45° FOV
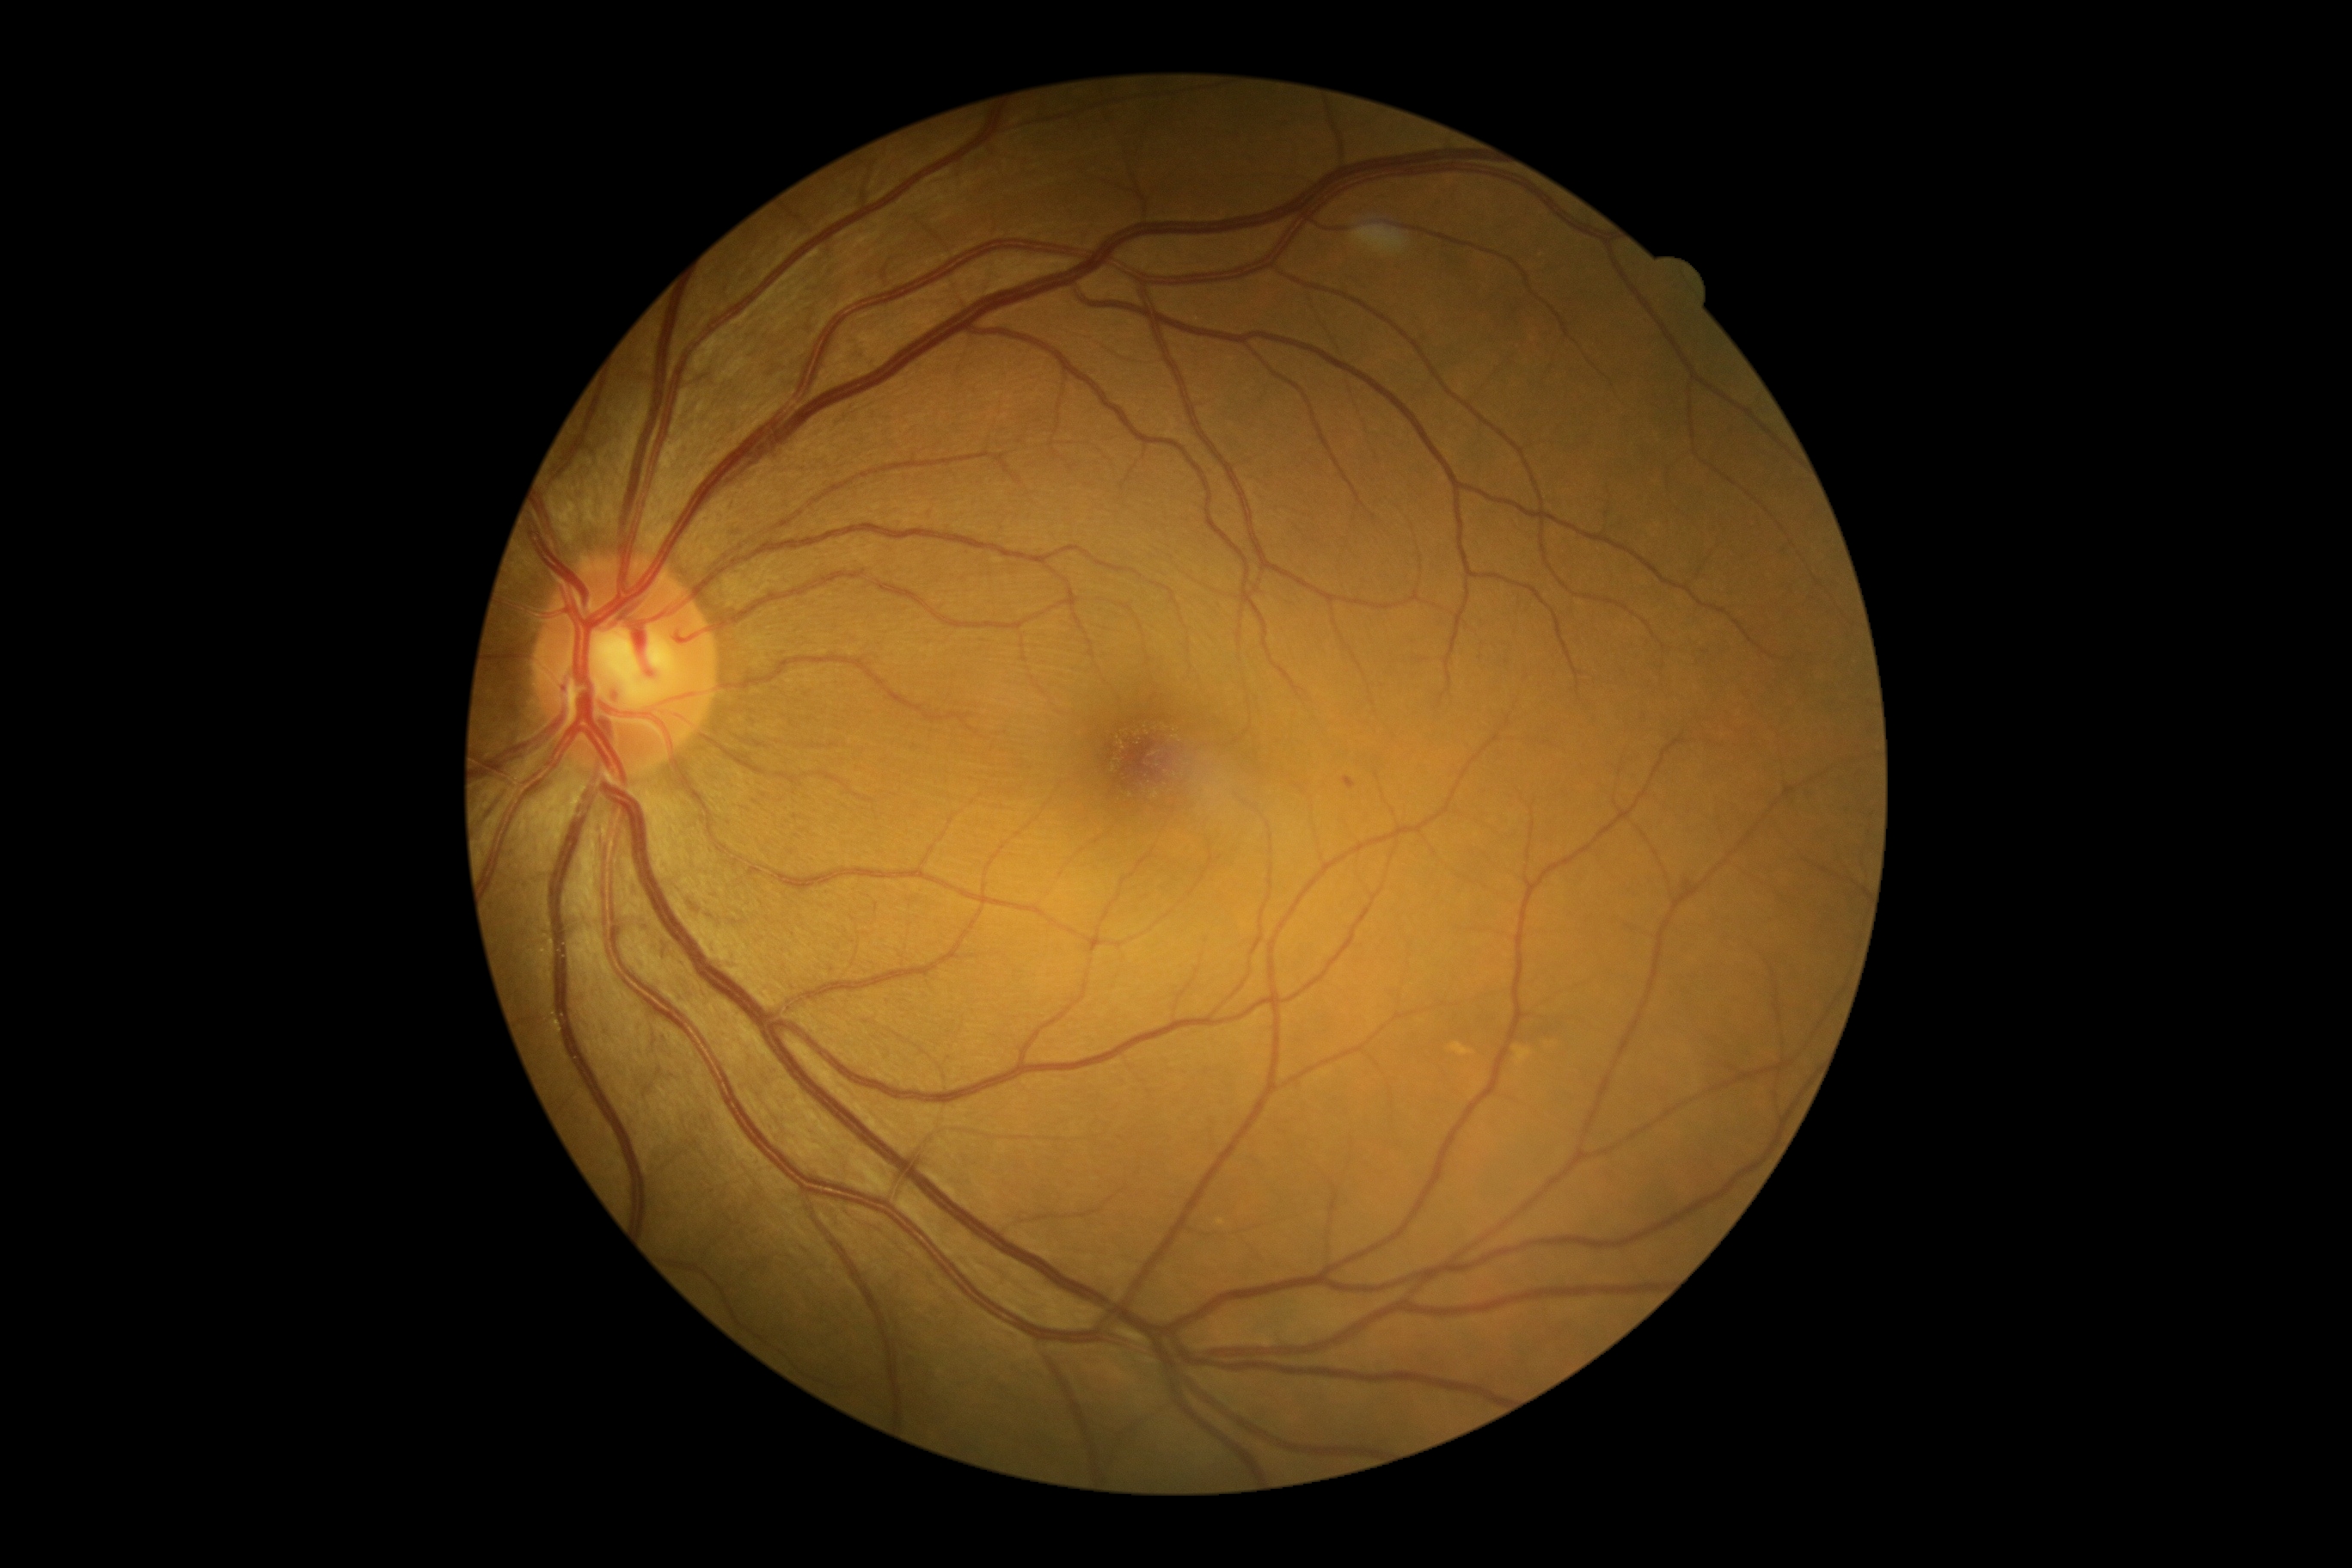 DR stage is grade 1 (mild NPDR); non-proliferative diabetic retinopathy
SEs = none
EXs = none
MAs = 1344:778:1356:790; 1682:883:1691:893
HEs = none